NIDEK AFC-230. Davis DR grading. 848x848. Without pupil dilation — 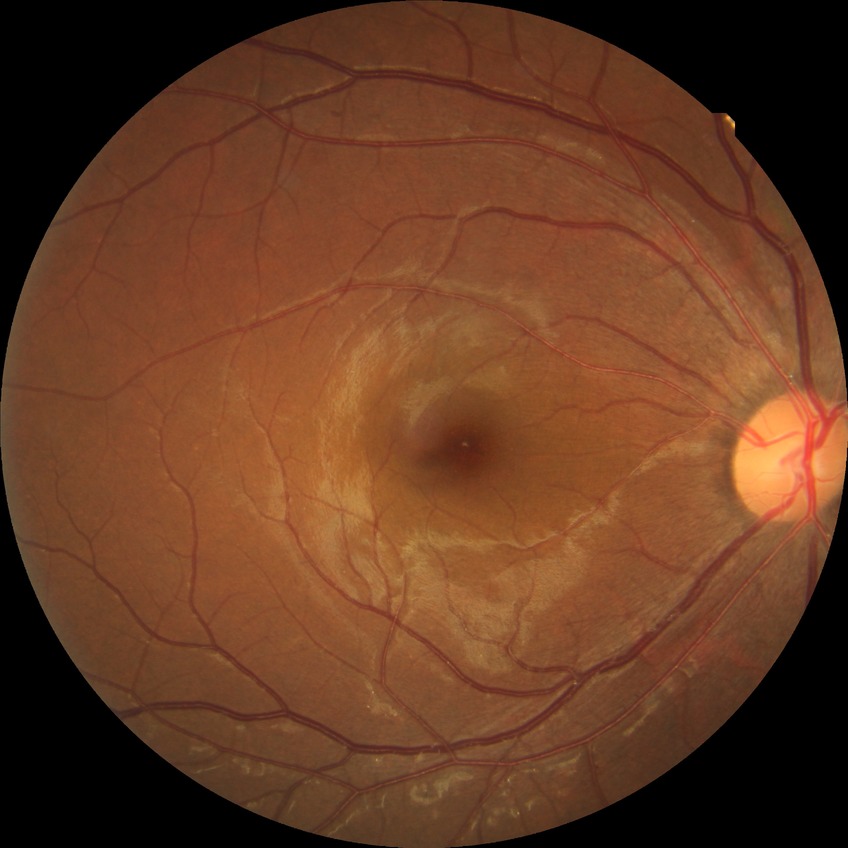 DR stage: SDR.